Nidek AFC-330; CFP; 240x240.
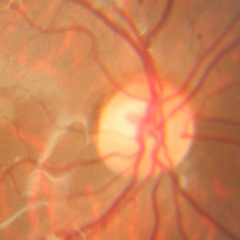

Q: What stage of glaucoma is present?
A: No glaucoma.